Image size 848x848.
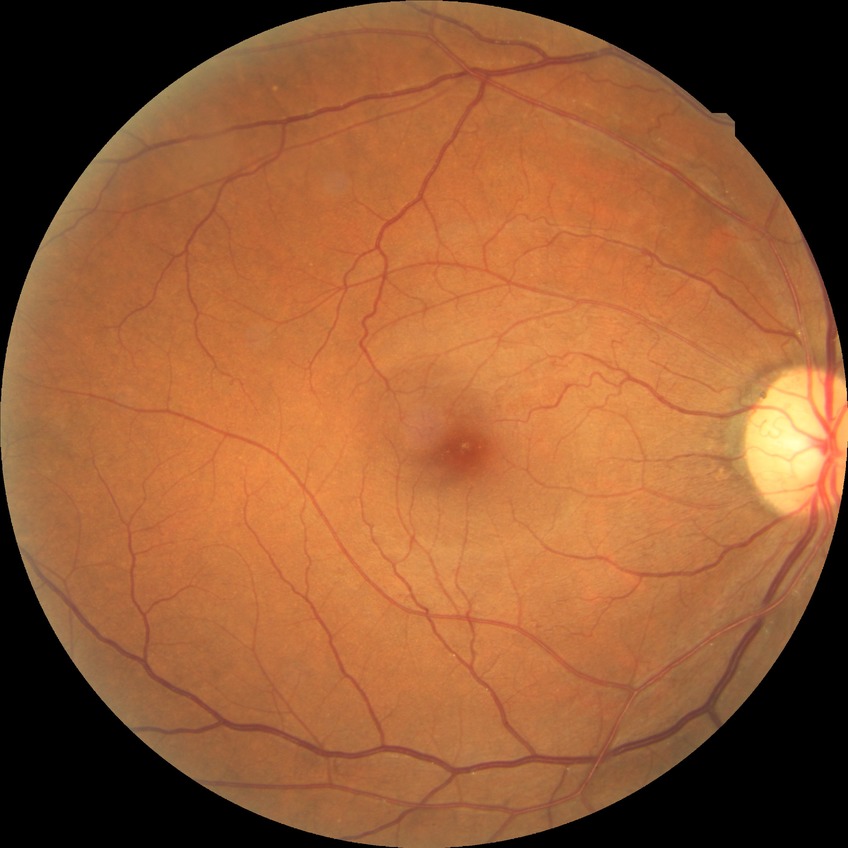 diabetic retinopathy (DR)@no diabetic retinopathy (NDR).